CFP — 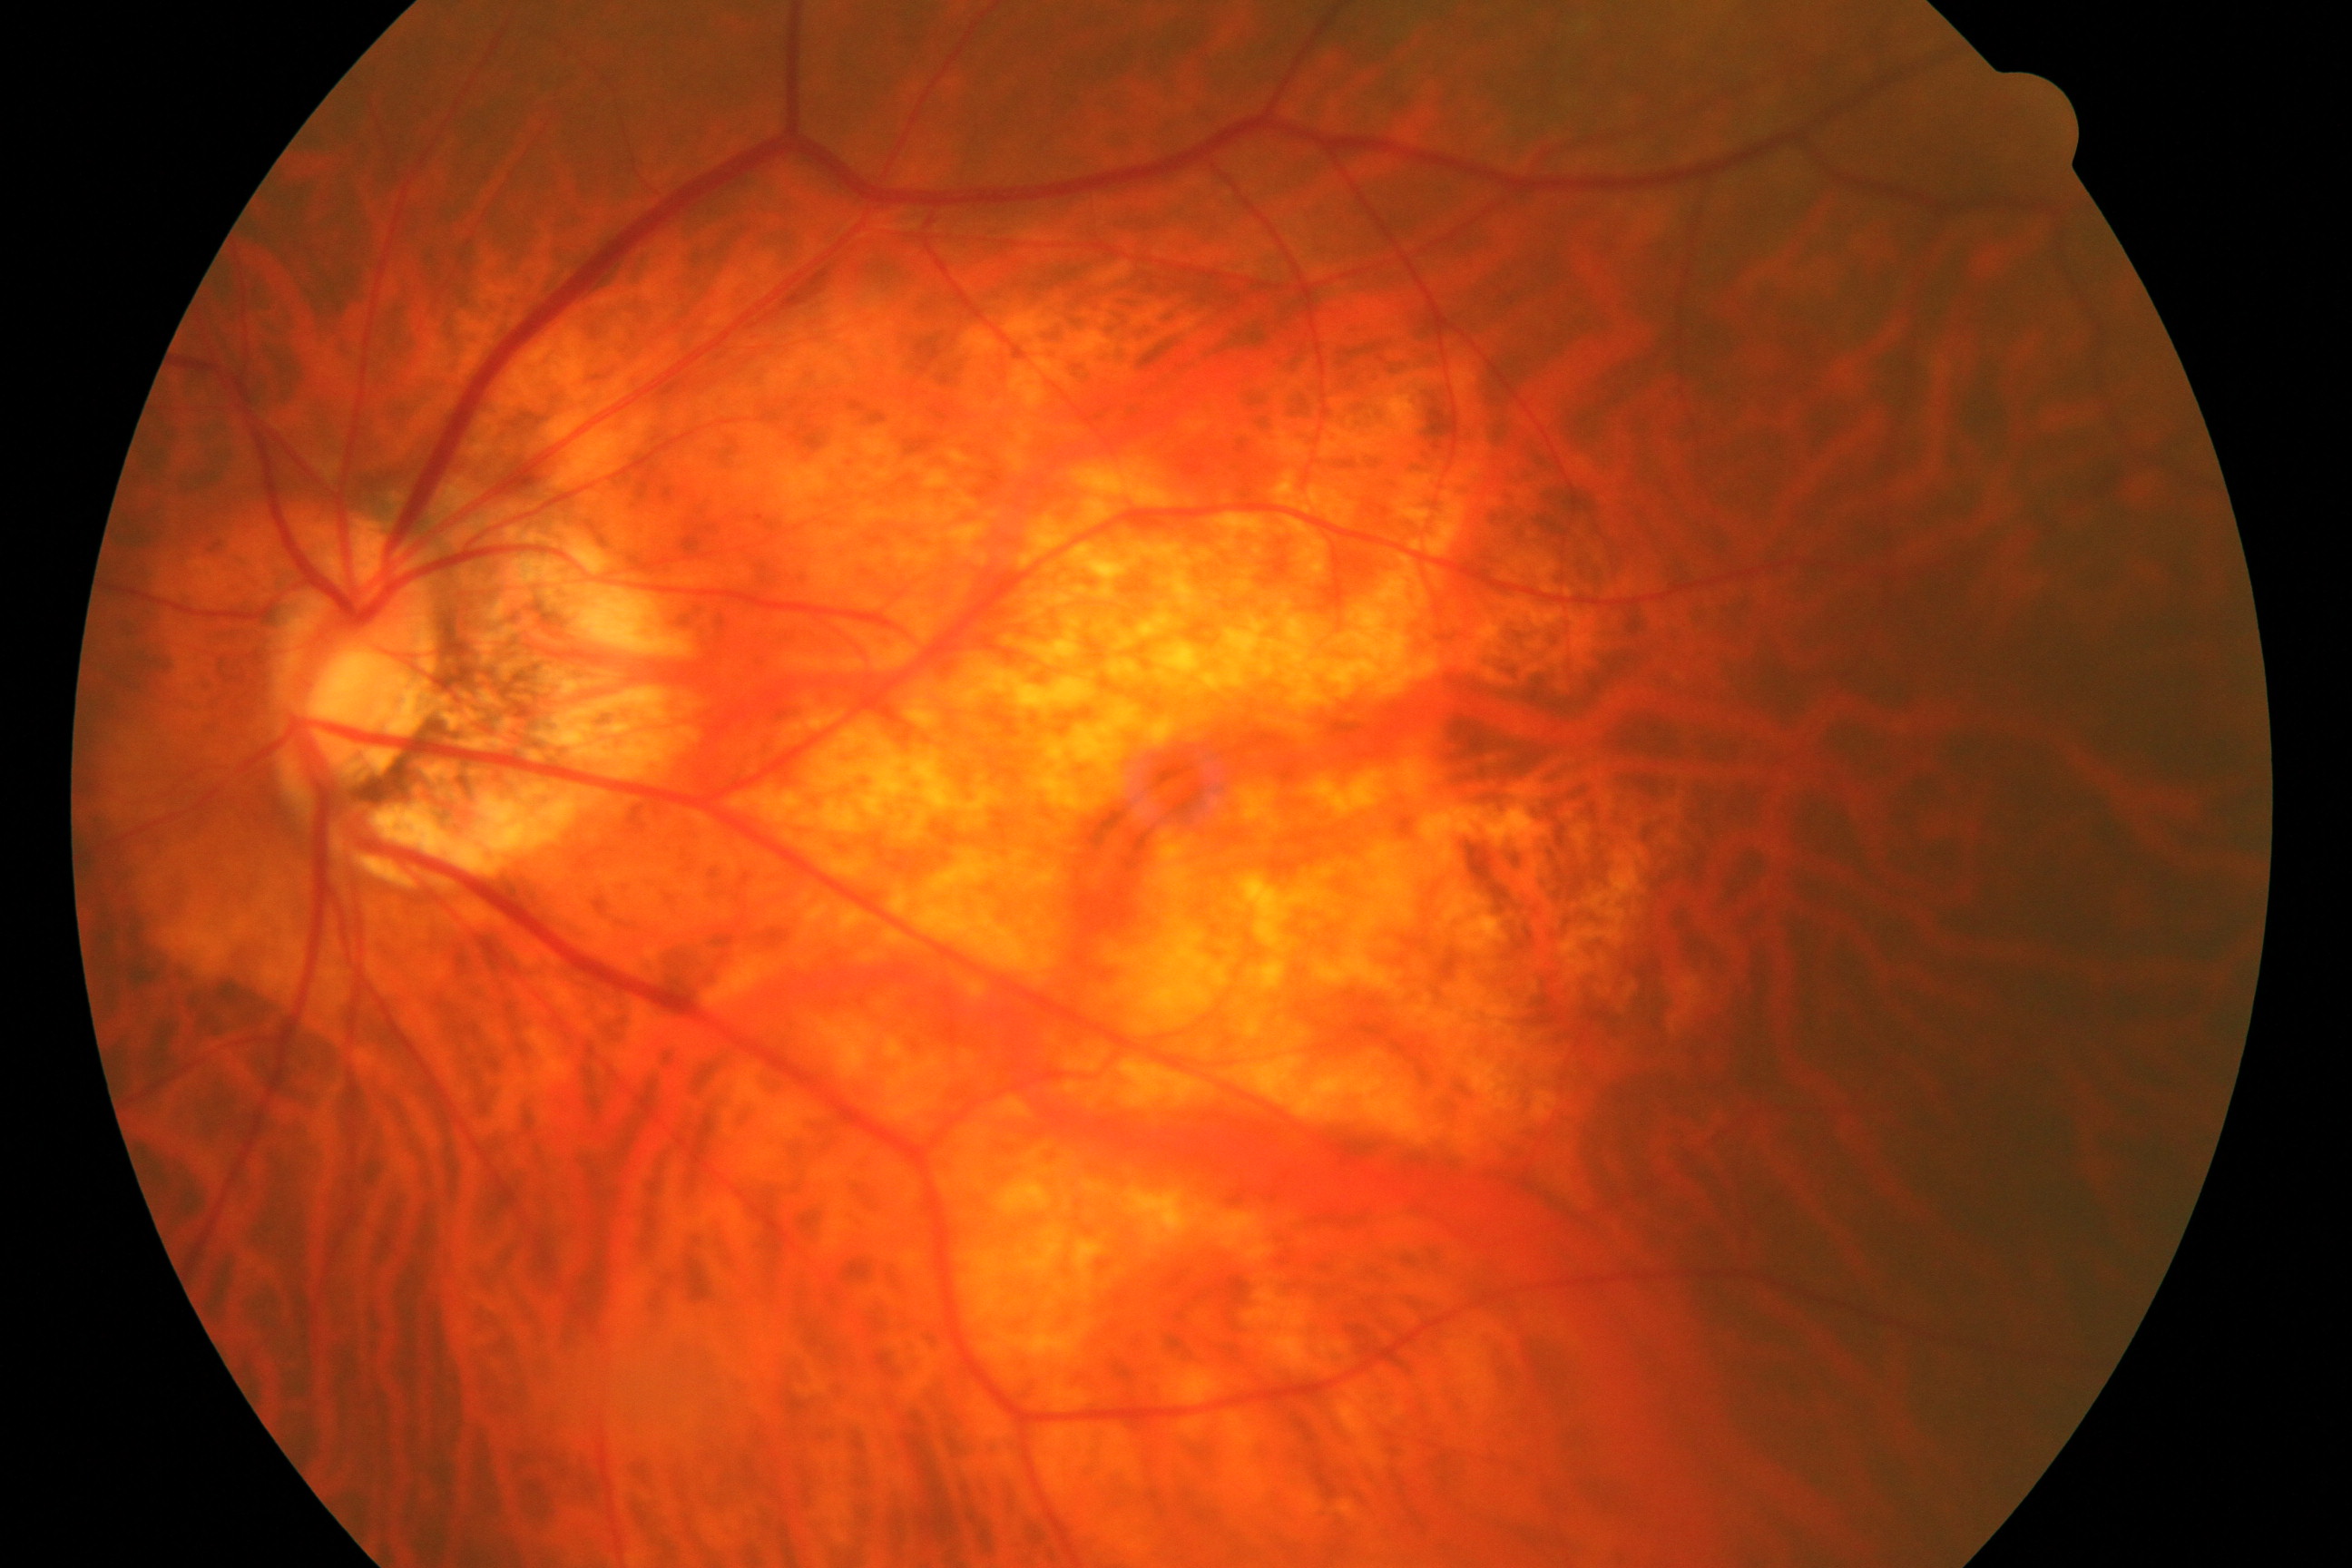

Classification: pathological myopia.